Wide-field fundus photograph of an infant. Clarity RetCam 3, 130° FOV — 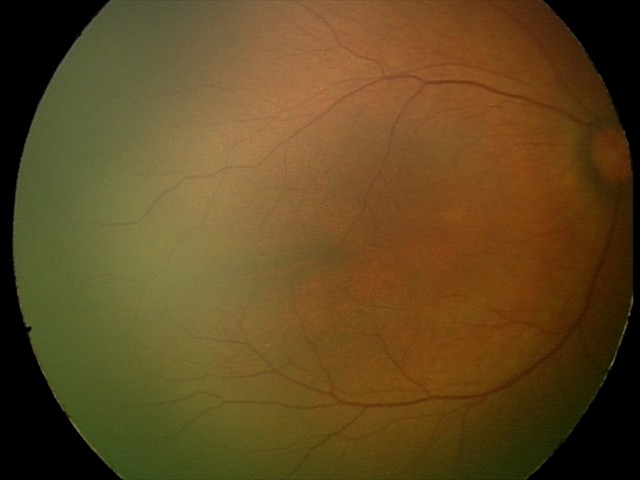

Normal screening examination.